2212x1672px — 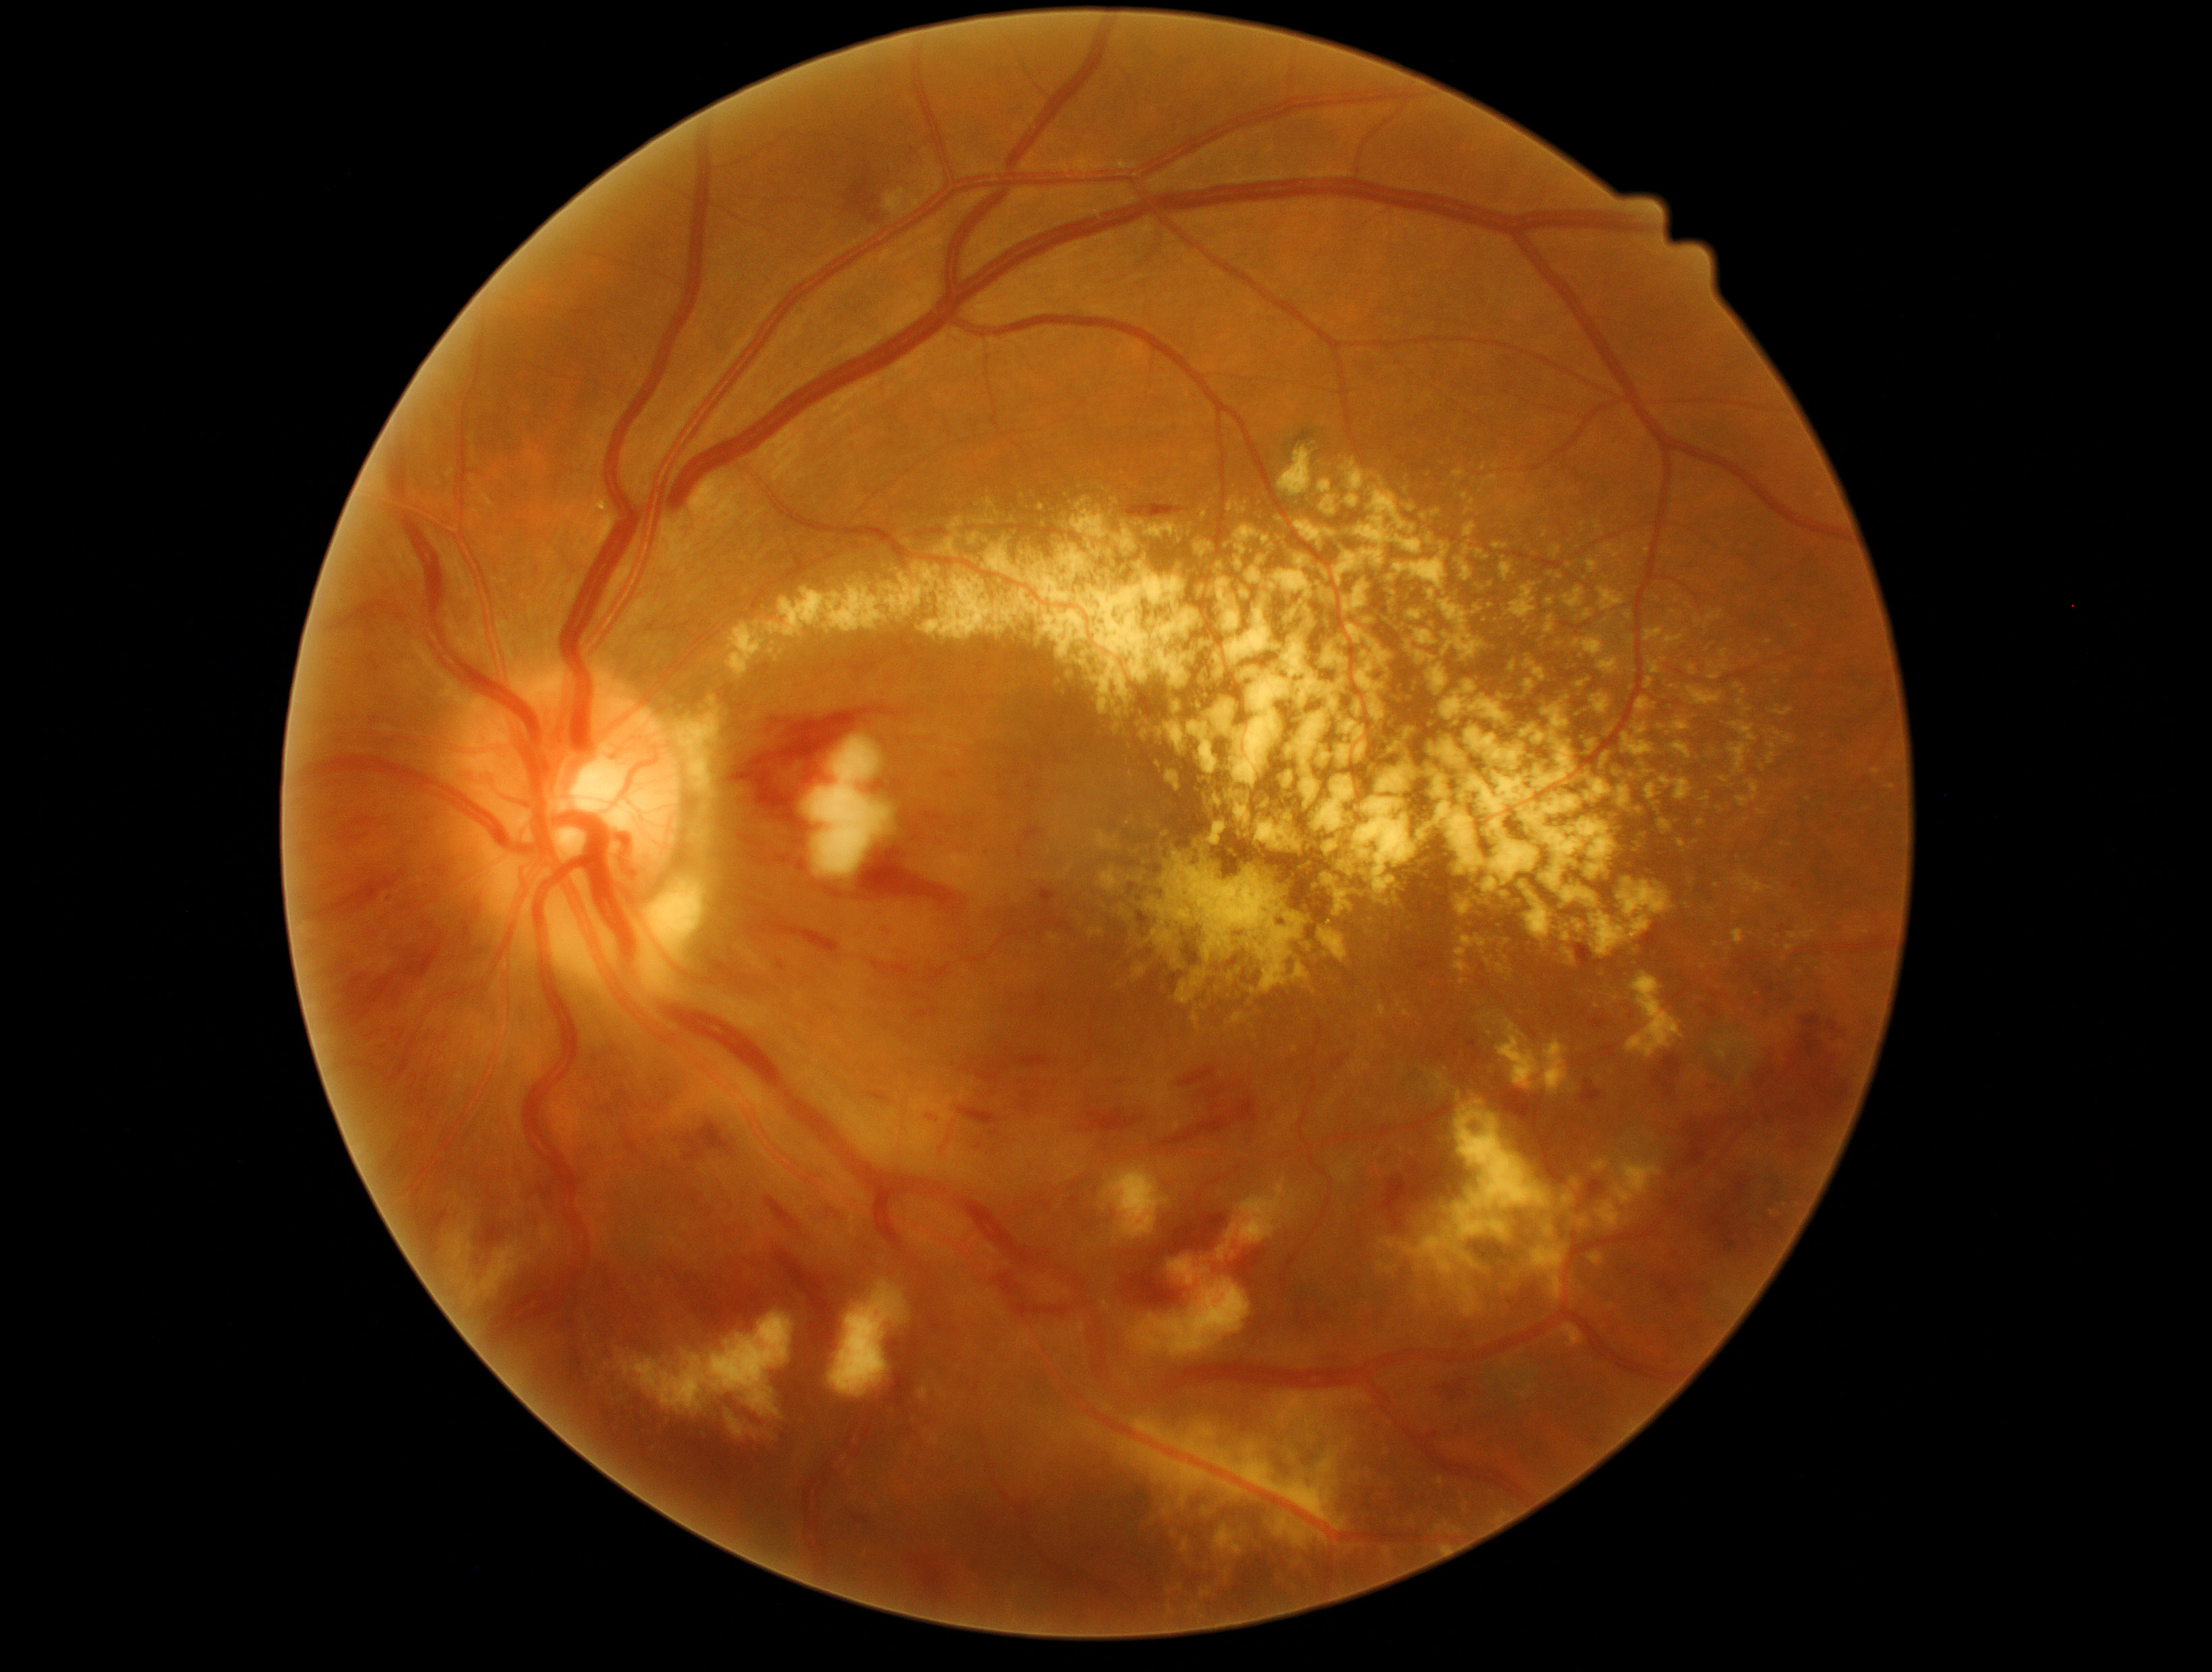
{"partial": true, "dr_grade": 3, "lesions": {"he": [[1126, 498, 1196, 518], [1706, 1081, 1720, 1097], [1534, 1446, 1545, 1458], [1012, 1303, 1073, 1319], [403, 932, 446, 982], [323, 811, 341, 822], [730, 705, 911, 835], [709, 959, 740, 985], [332, 812, 377, 849], [1066, 1194, 1080, 1217], [765, 1195, 801, 1229], [853, 843, 957, 907], [341, 969, 403, 1028], [622, 1124, 640, 1156], [1587, 1182, 1606, 1201], [740, 852, 771, 868], [610, 1046, 620, 1054]], "he_small_approx": [[1090, 1108], [1796, 886]], "ma": null, "se": [[1128, 1279, 1251, 1357], [463, 1241, 532, 1307], [1169, 1256, 1198, 1286], [829, 1279, 906, 1399], [1100, 1166, 1171, 1244], [724, 1410, 774, 1447], [806, 736, 892, 878], [539, 1226, 558, 1252], [1217, 1176, 1300, 1260], [439, 1194, 477, 1283], [617, 1314, 792, 1419]], "ex": [[1100, 868, 1122, 892], [1138, 520, 1189, 541], [1376, 1001, 1390, 1020], [1635, 700, 1654, 717], [728, 532, 1212, 757], [1127, 819, 1135, 826], [1113, 1435, 1252, 1522], [1039, 505, 1045, 513], [1291, 518, 1339, 551], [1556, 541, 1563, 555], [1580, 632, 1602, 660], [1544, 595, 1553, 609], [1406, 601, 1429, 620], [1076, 498, 1090, 510], [1689, 657, 1699, 679], [1596, 1199, 1621, 1232], [1482, 908, 1513, 985], [1229, 522, 1281, 602]], "ex_small_approx": [[1769, 642], [1129, 747]]}}